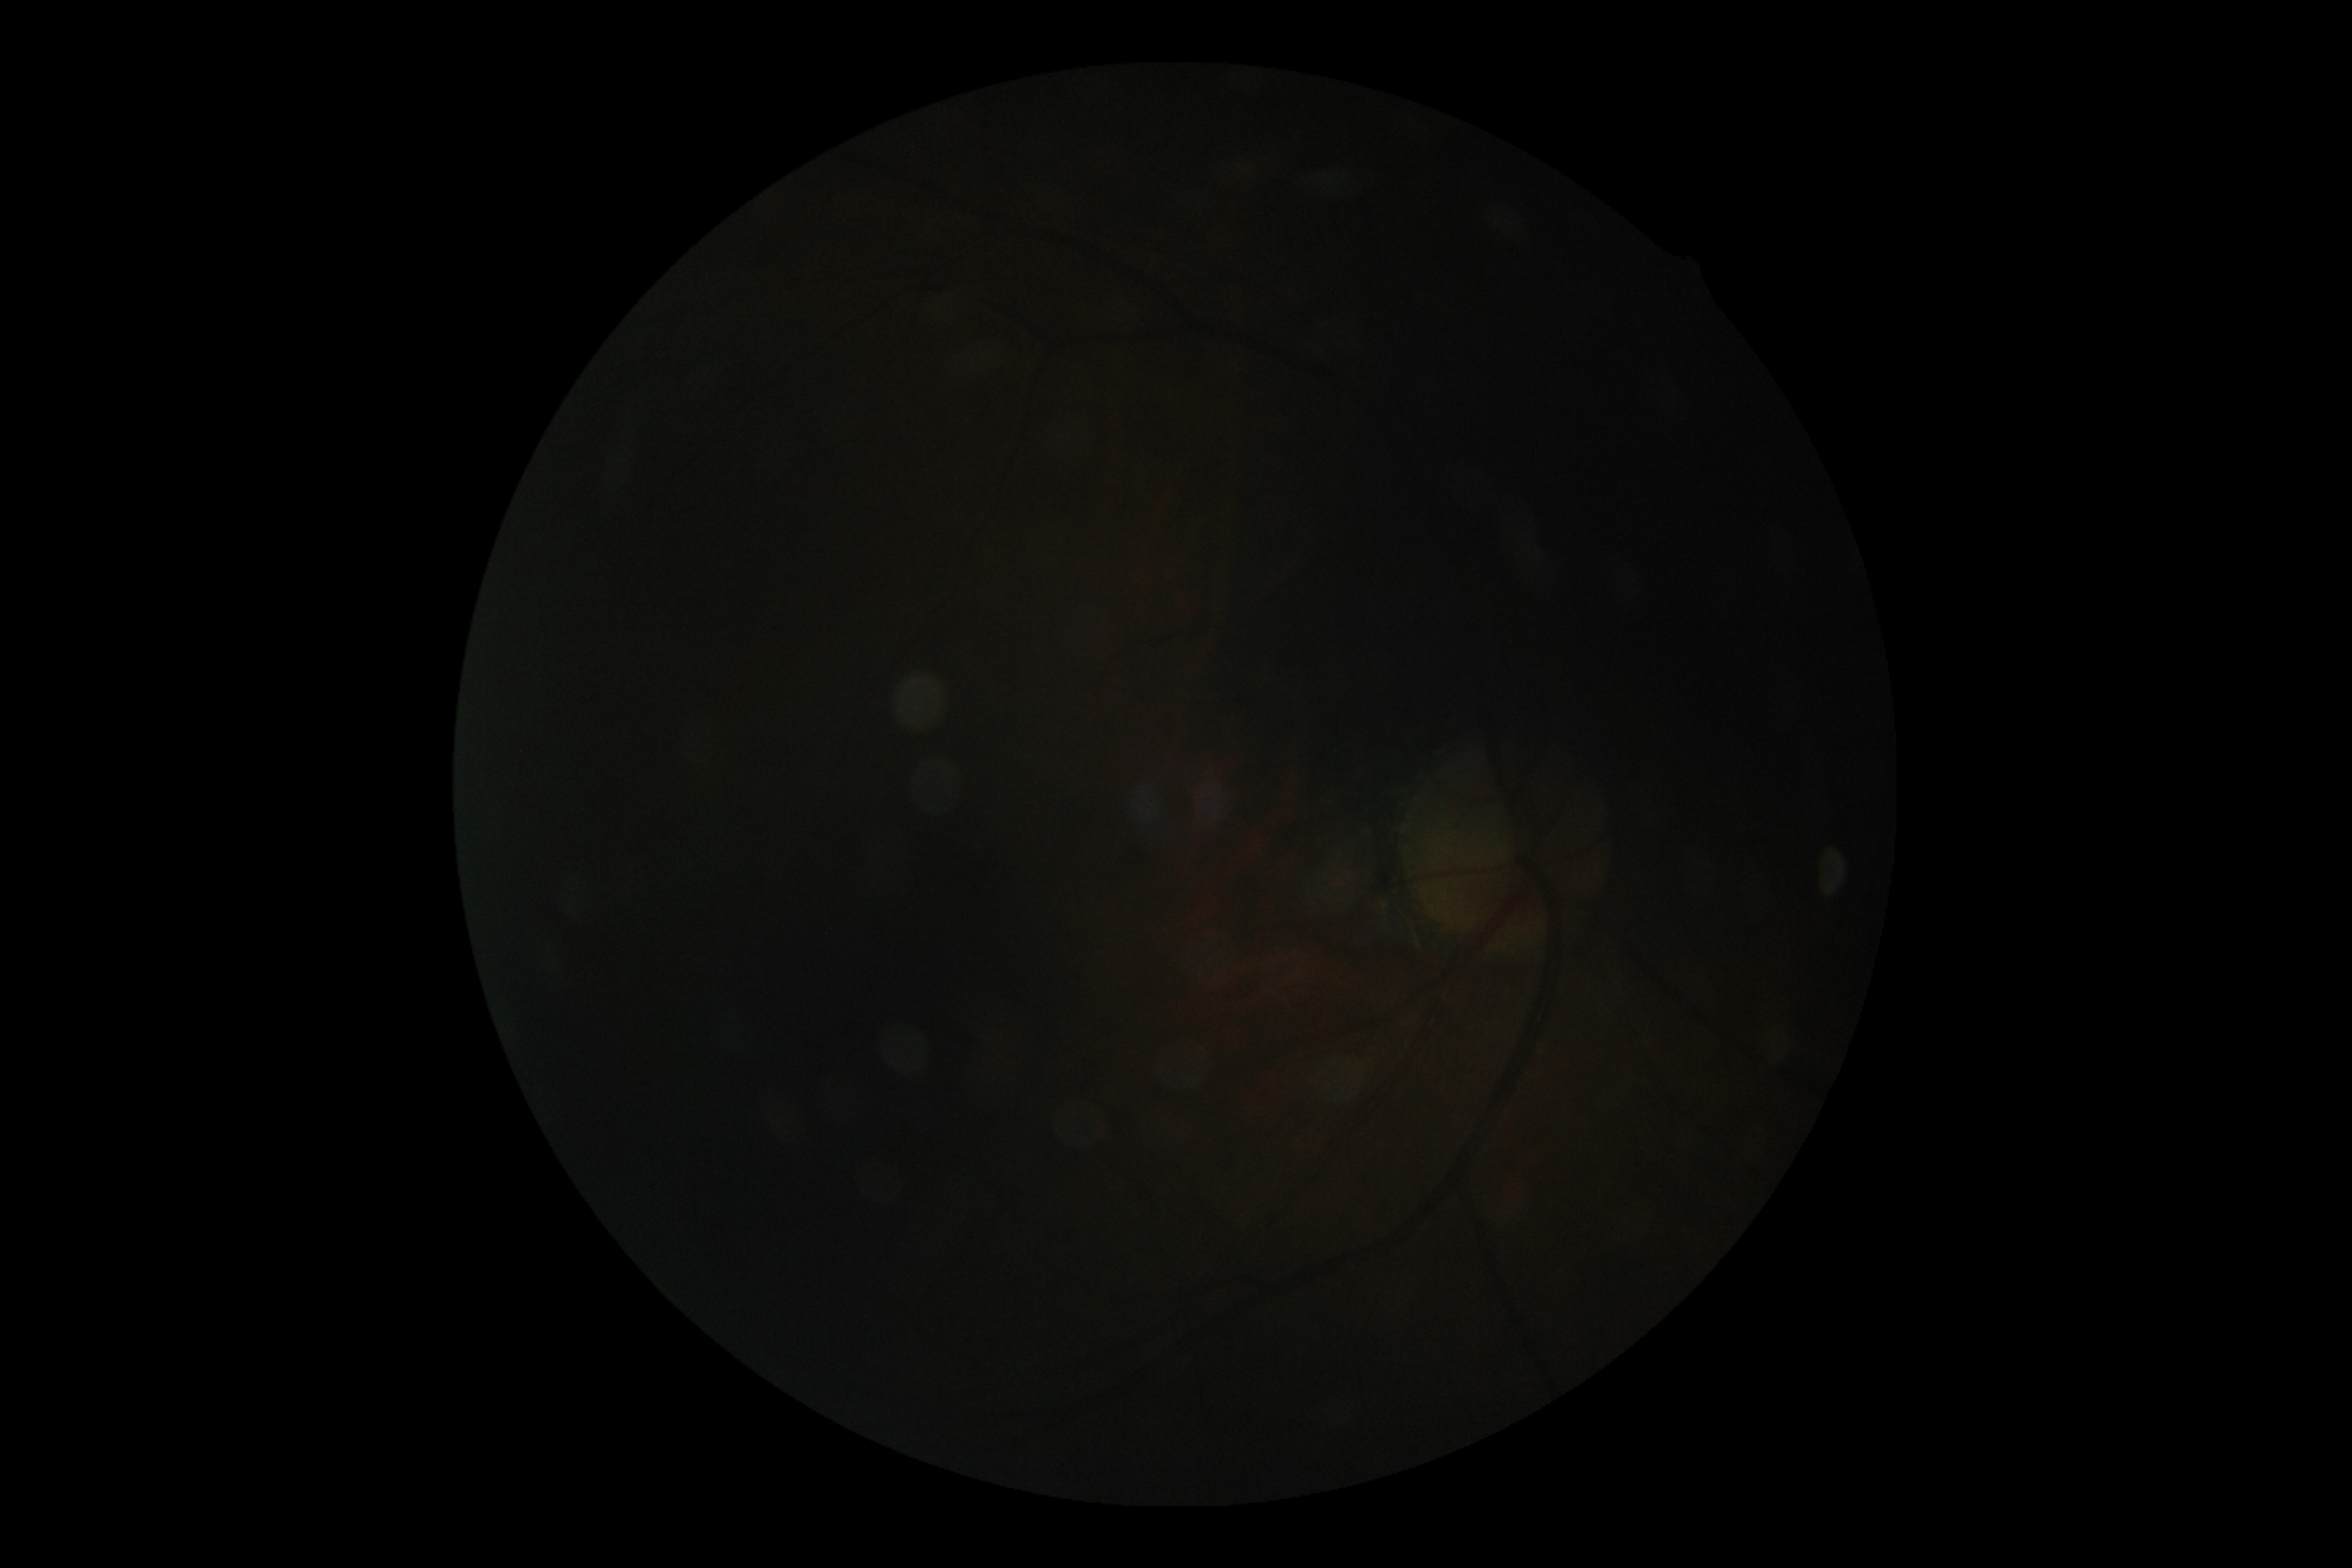 Ungradable image — DR severity cannot be determined.
Diabetic retinopathy (DR): ungradable due to poor image quality.